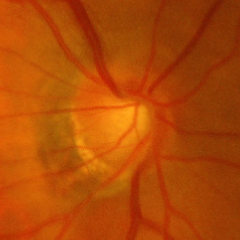
Glaucomatous changes are present.
Advanced-stage glaucoma.